Retinal fundus photograph. 2352x1568:
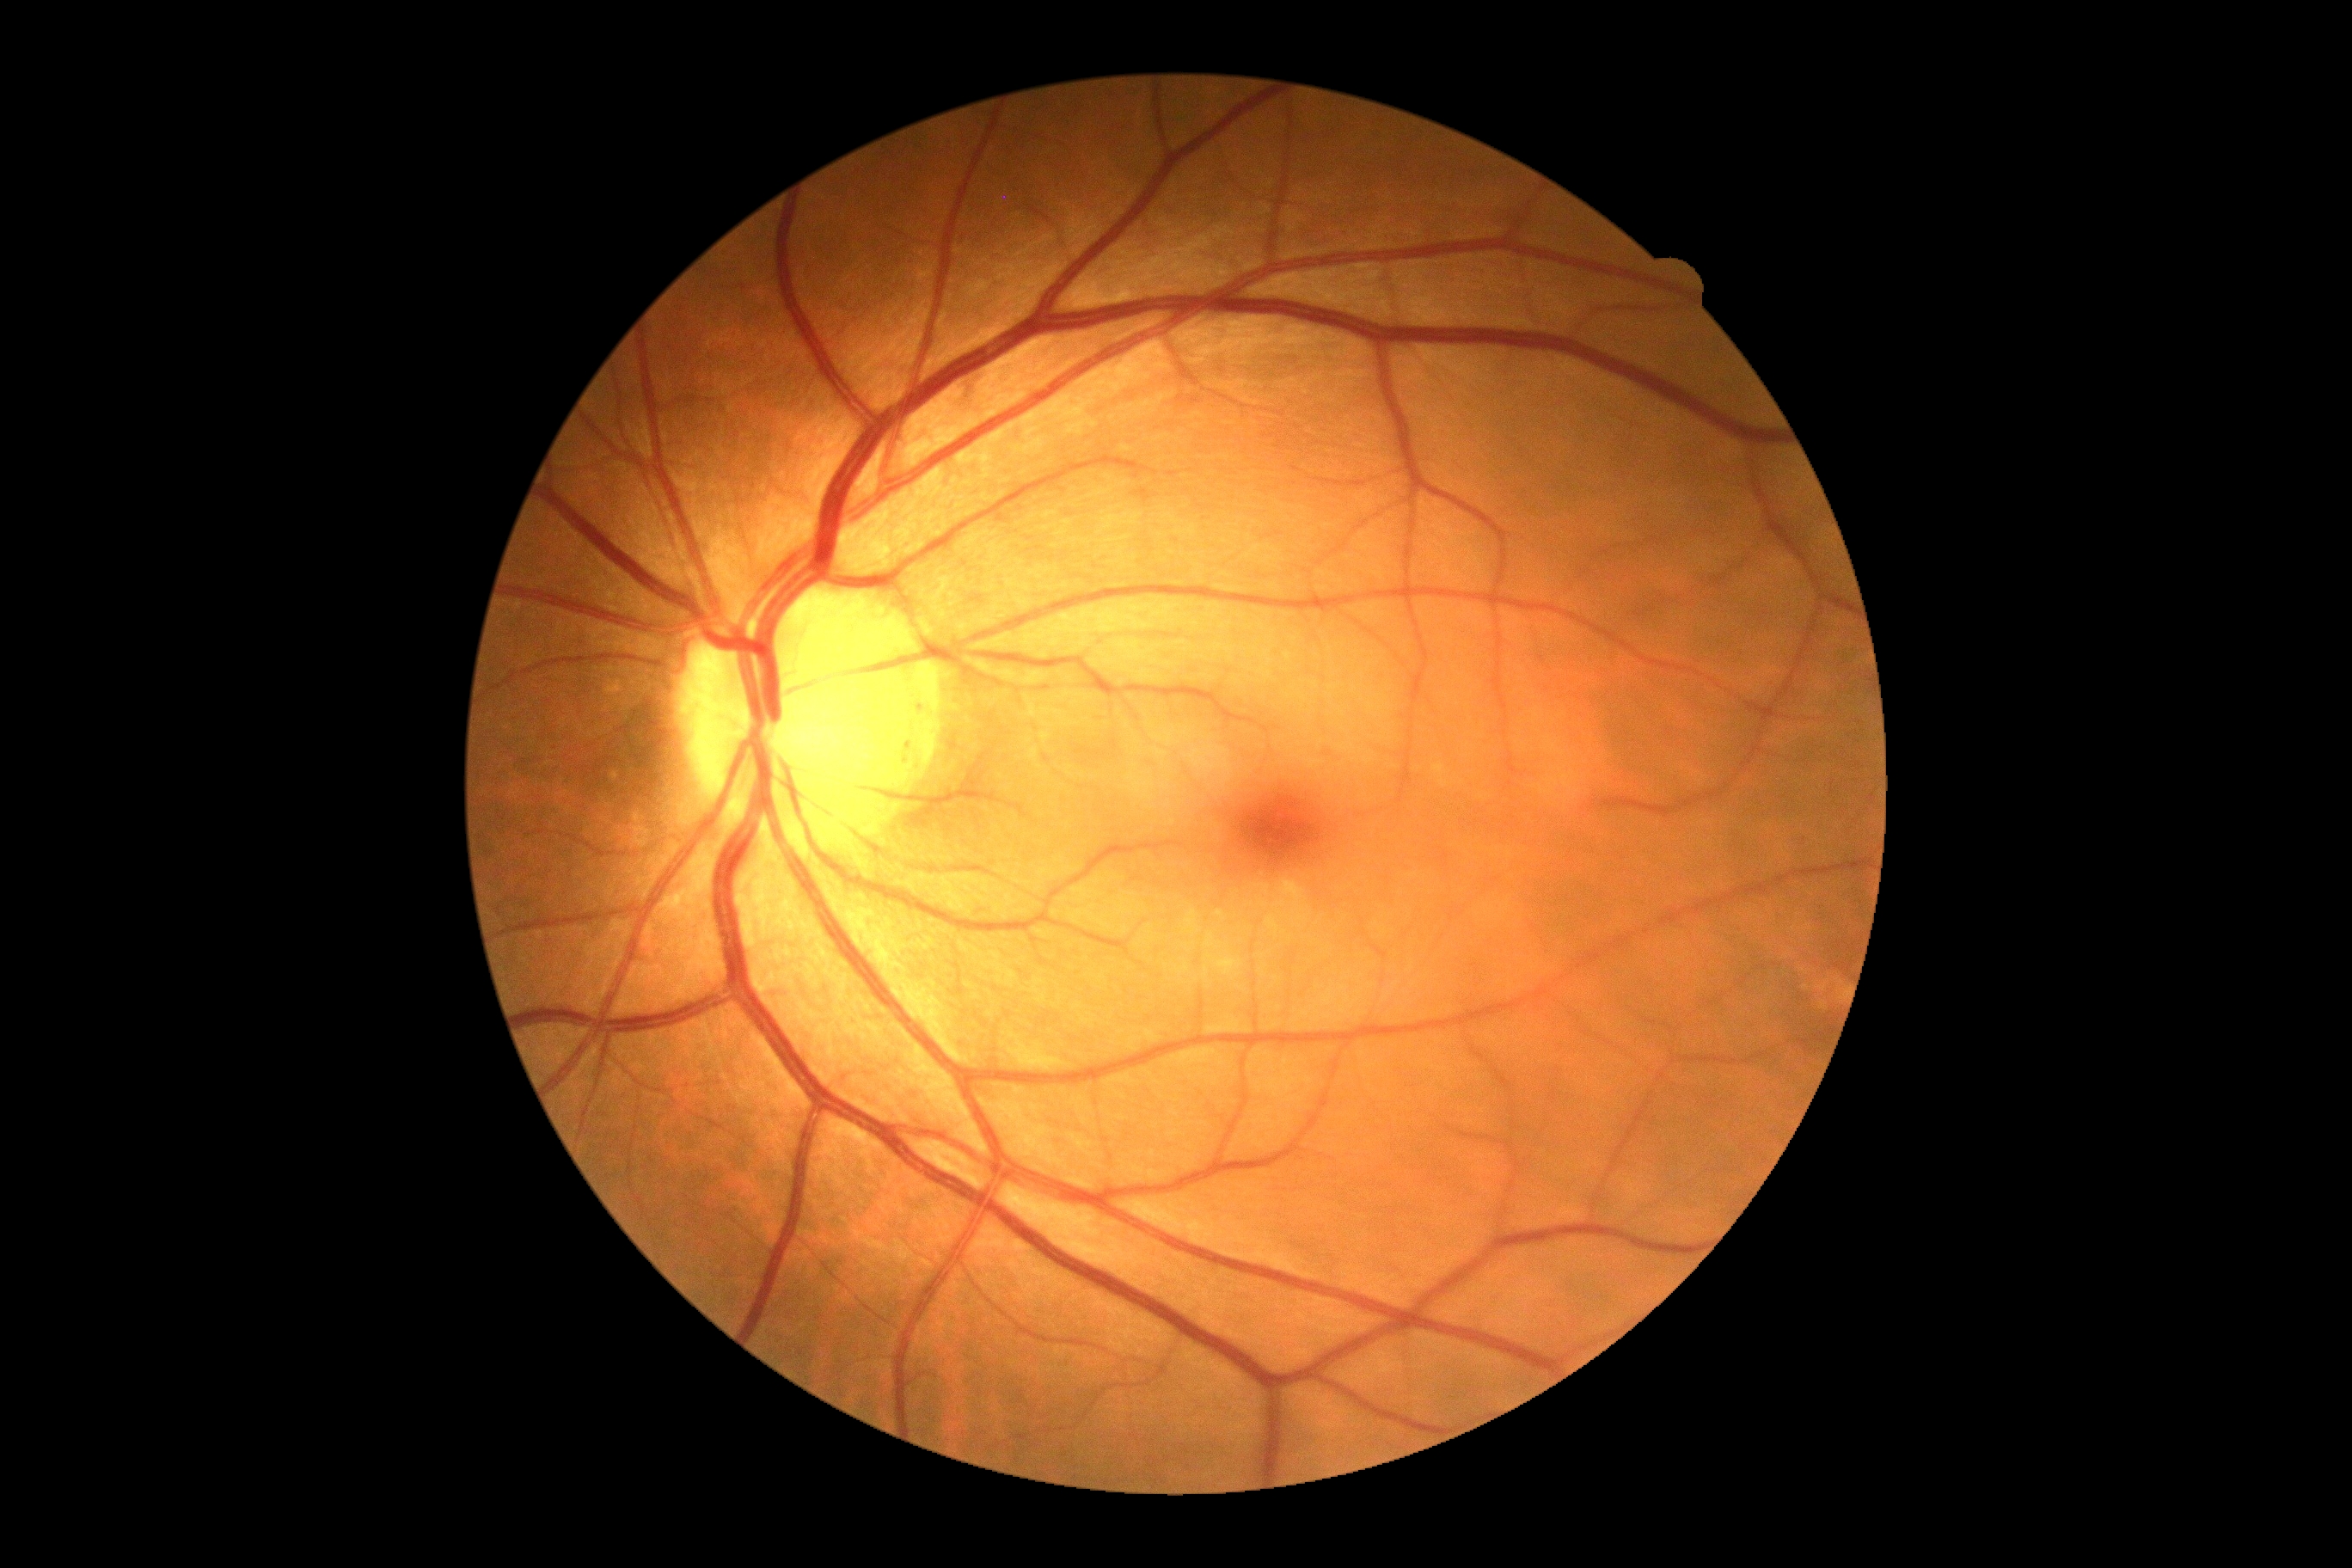

DR impression=no apparent DR; DR=0.